Graded on the modified Davis scale: 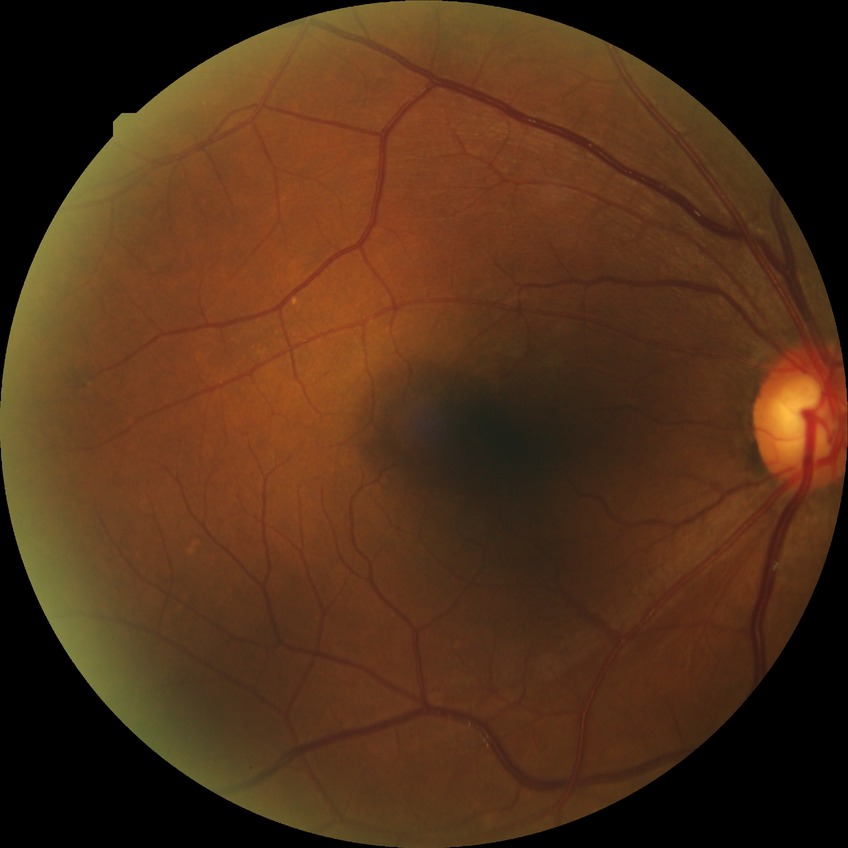 Diabetic retinopathy (DR): NDR (no diabetic retinopathy).